45° FOV.
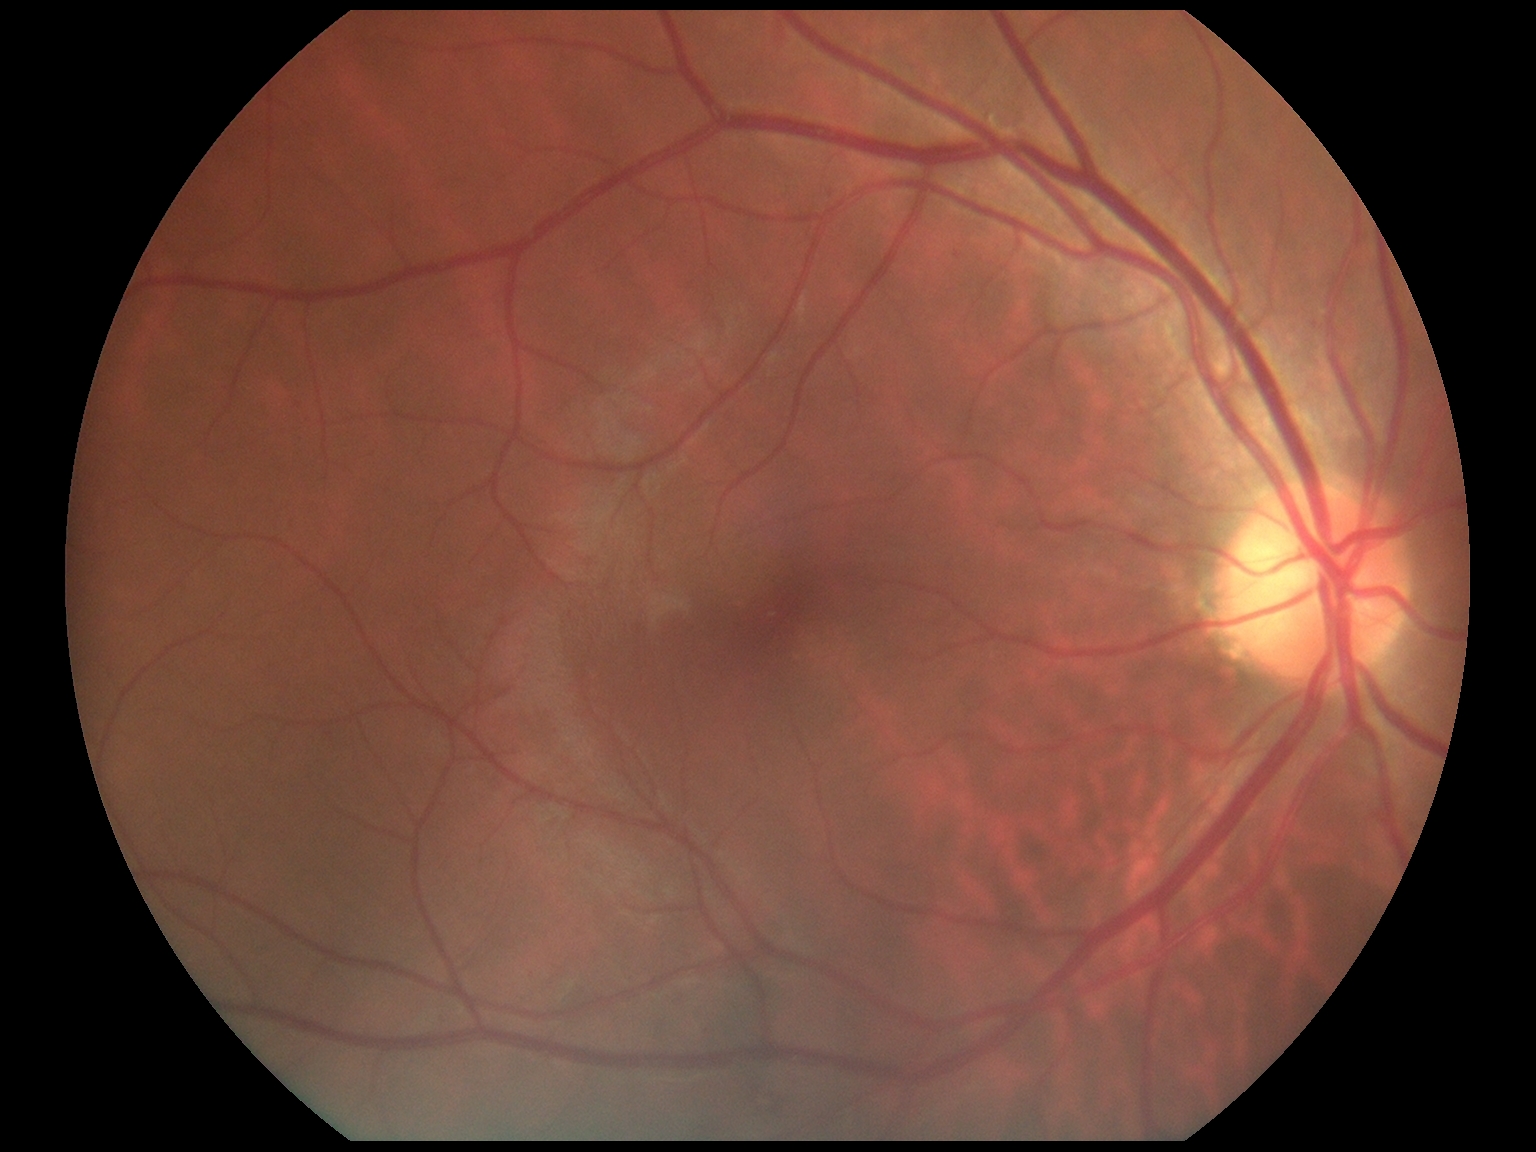
DR: 0/4 — no visible signs of diabetic retinopathy.